Optic disc region of a color fundus photo
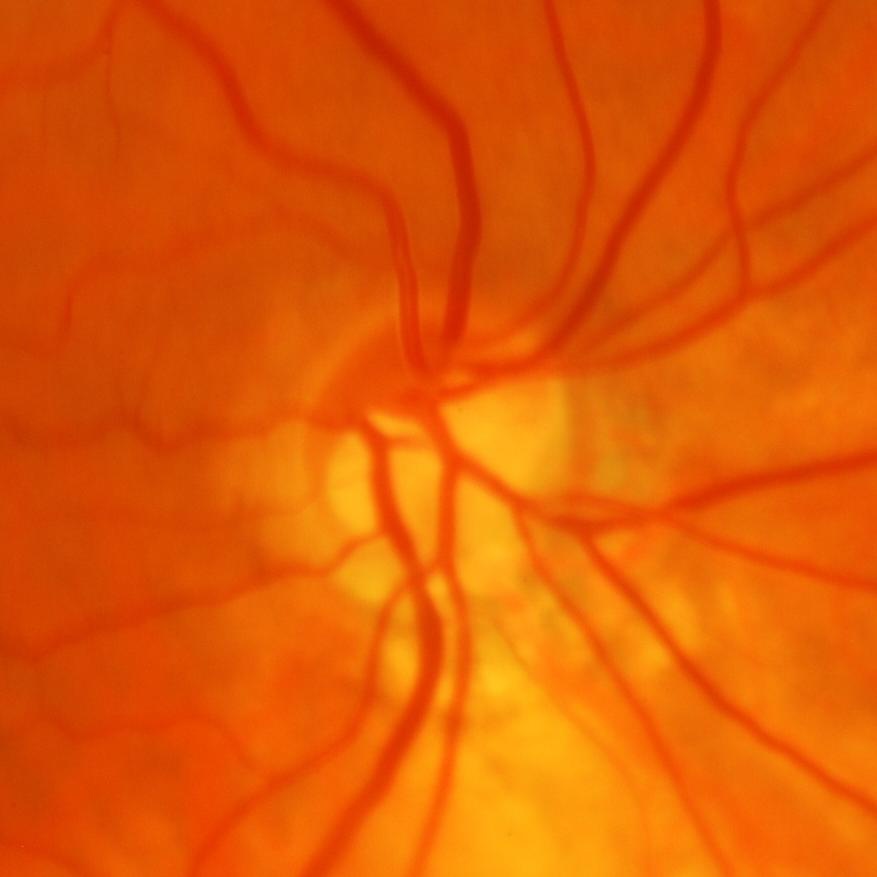 Glaucoma diagnosis = glaucomatous findings.